Modified Davis grading.
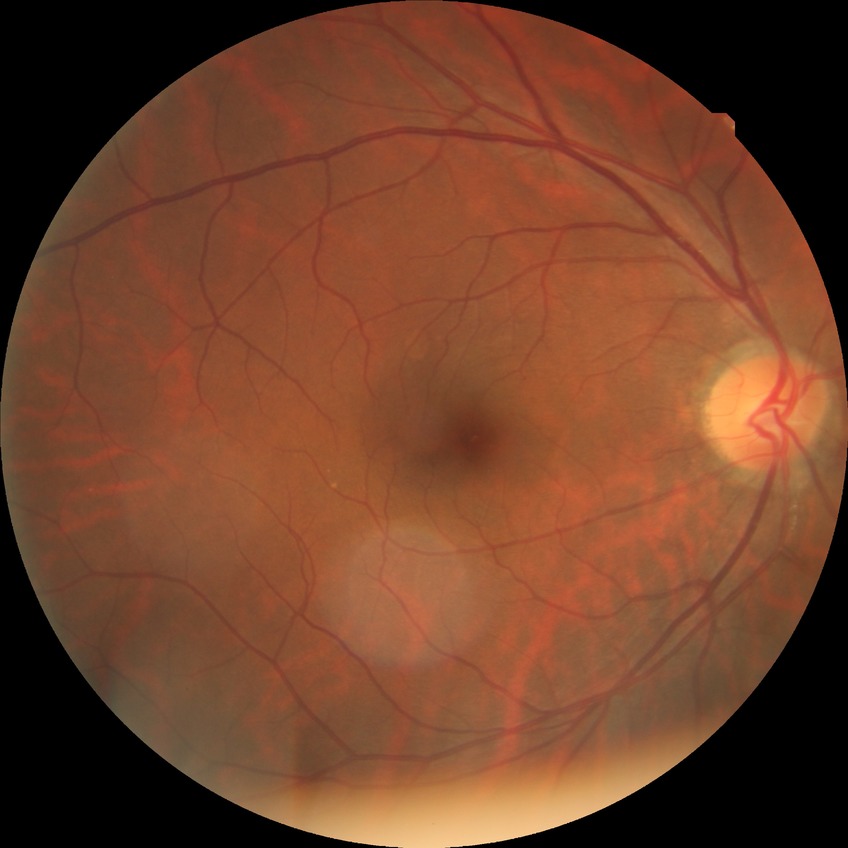 Davis DR grade is NDR.